Davis DR grading — 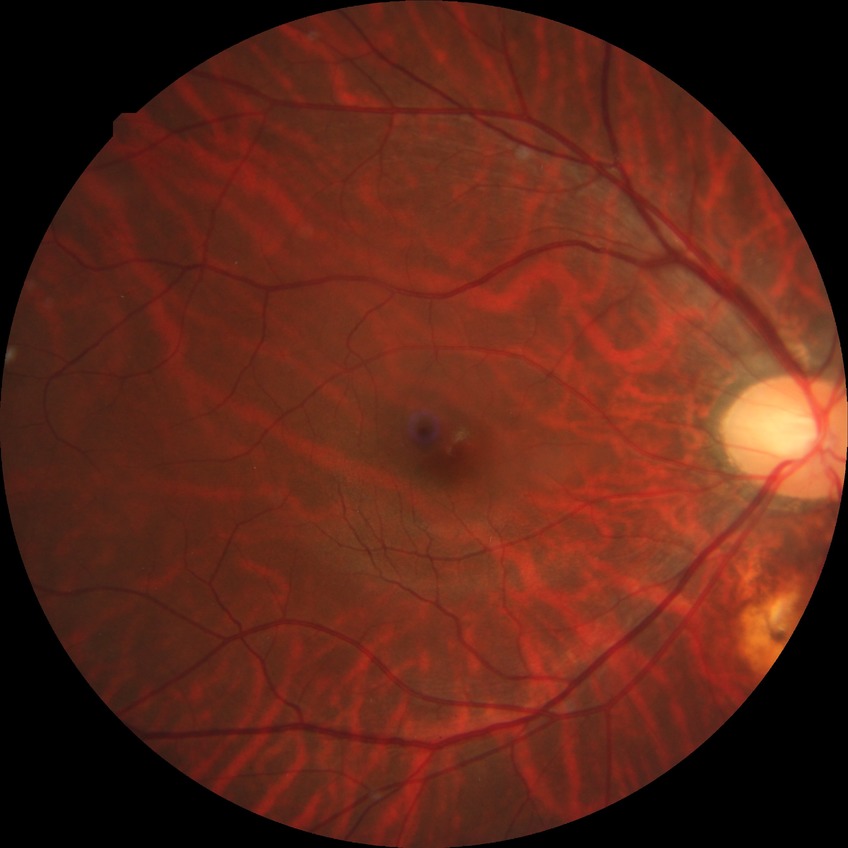

Diabetic retinopathy (DR): NDR (no diabetic retinopathy).